240 x 240 pixels — 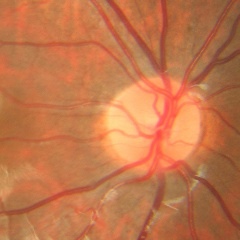

Assessment = no signs of glaucoma.